Portable fundus photograph
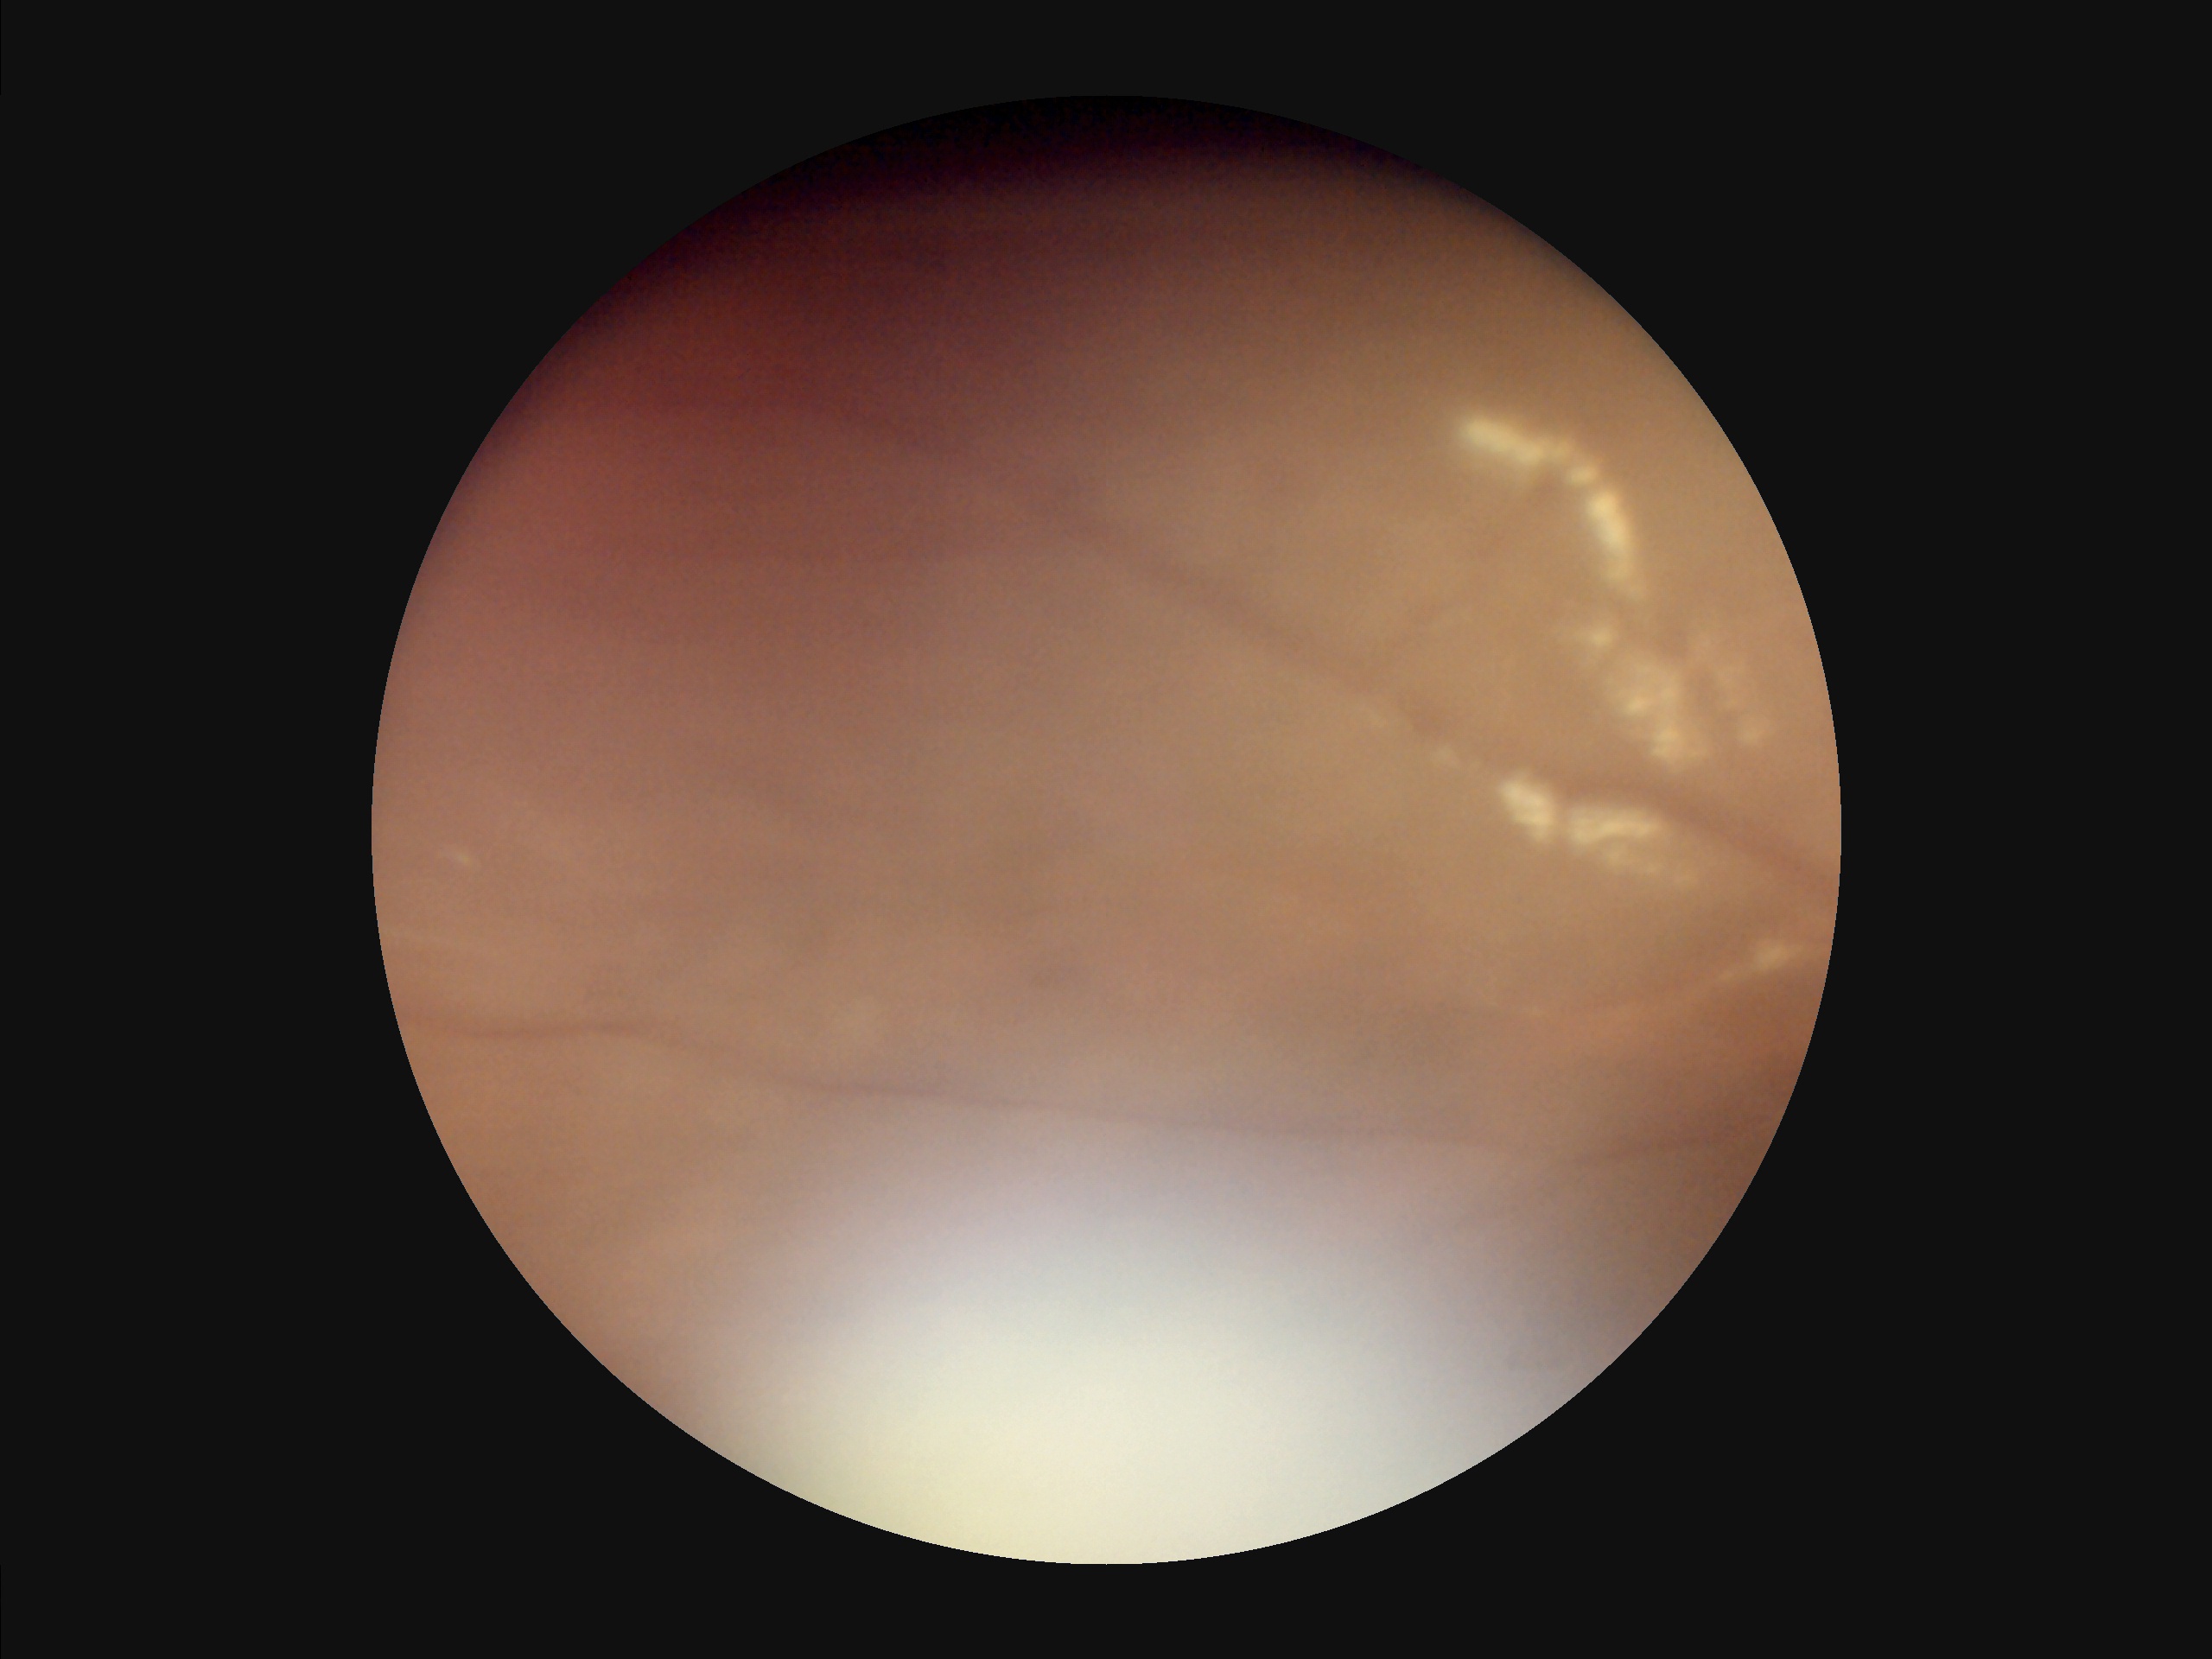

The image is blurry. Image quality is inadequate for diagnostic use. Illumination and color are suboptimal. Vessels and details are hard to distinguish.